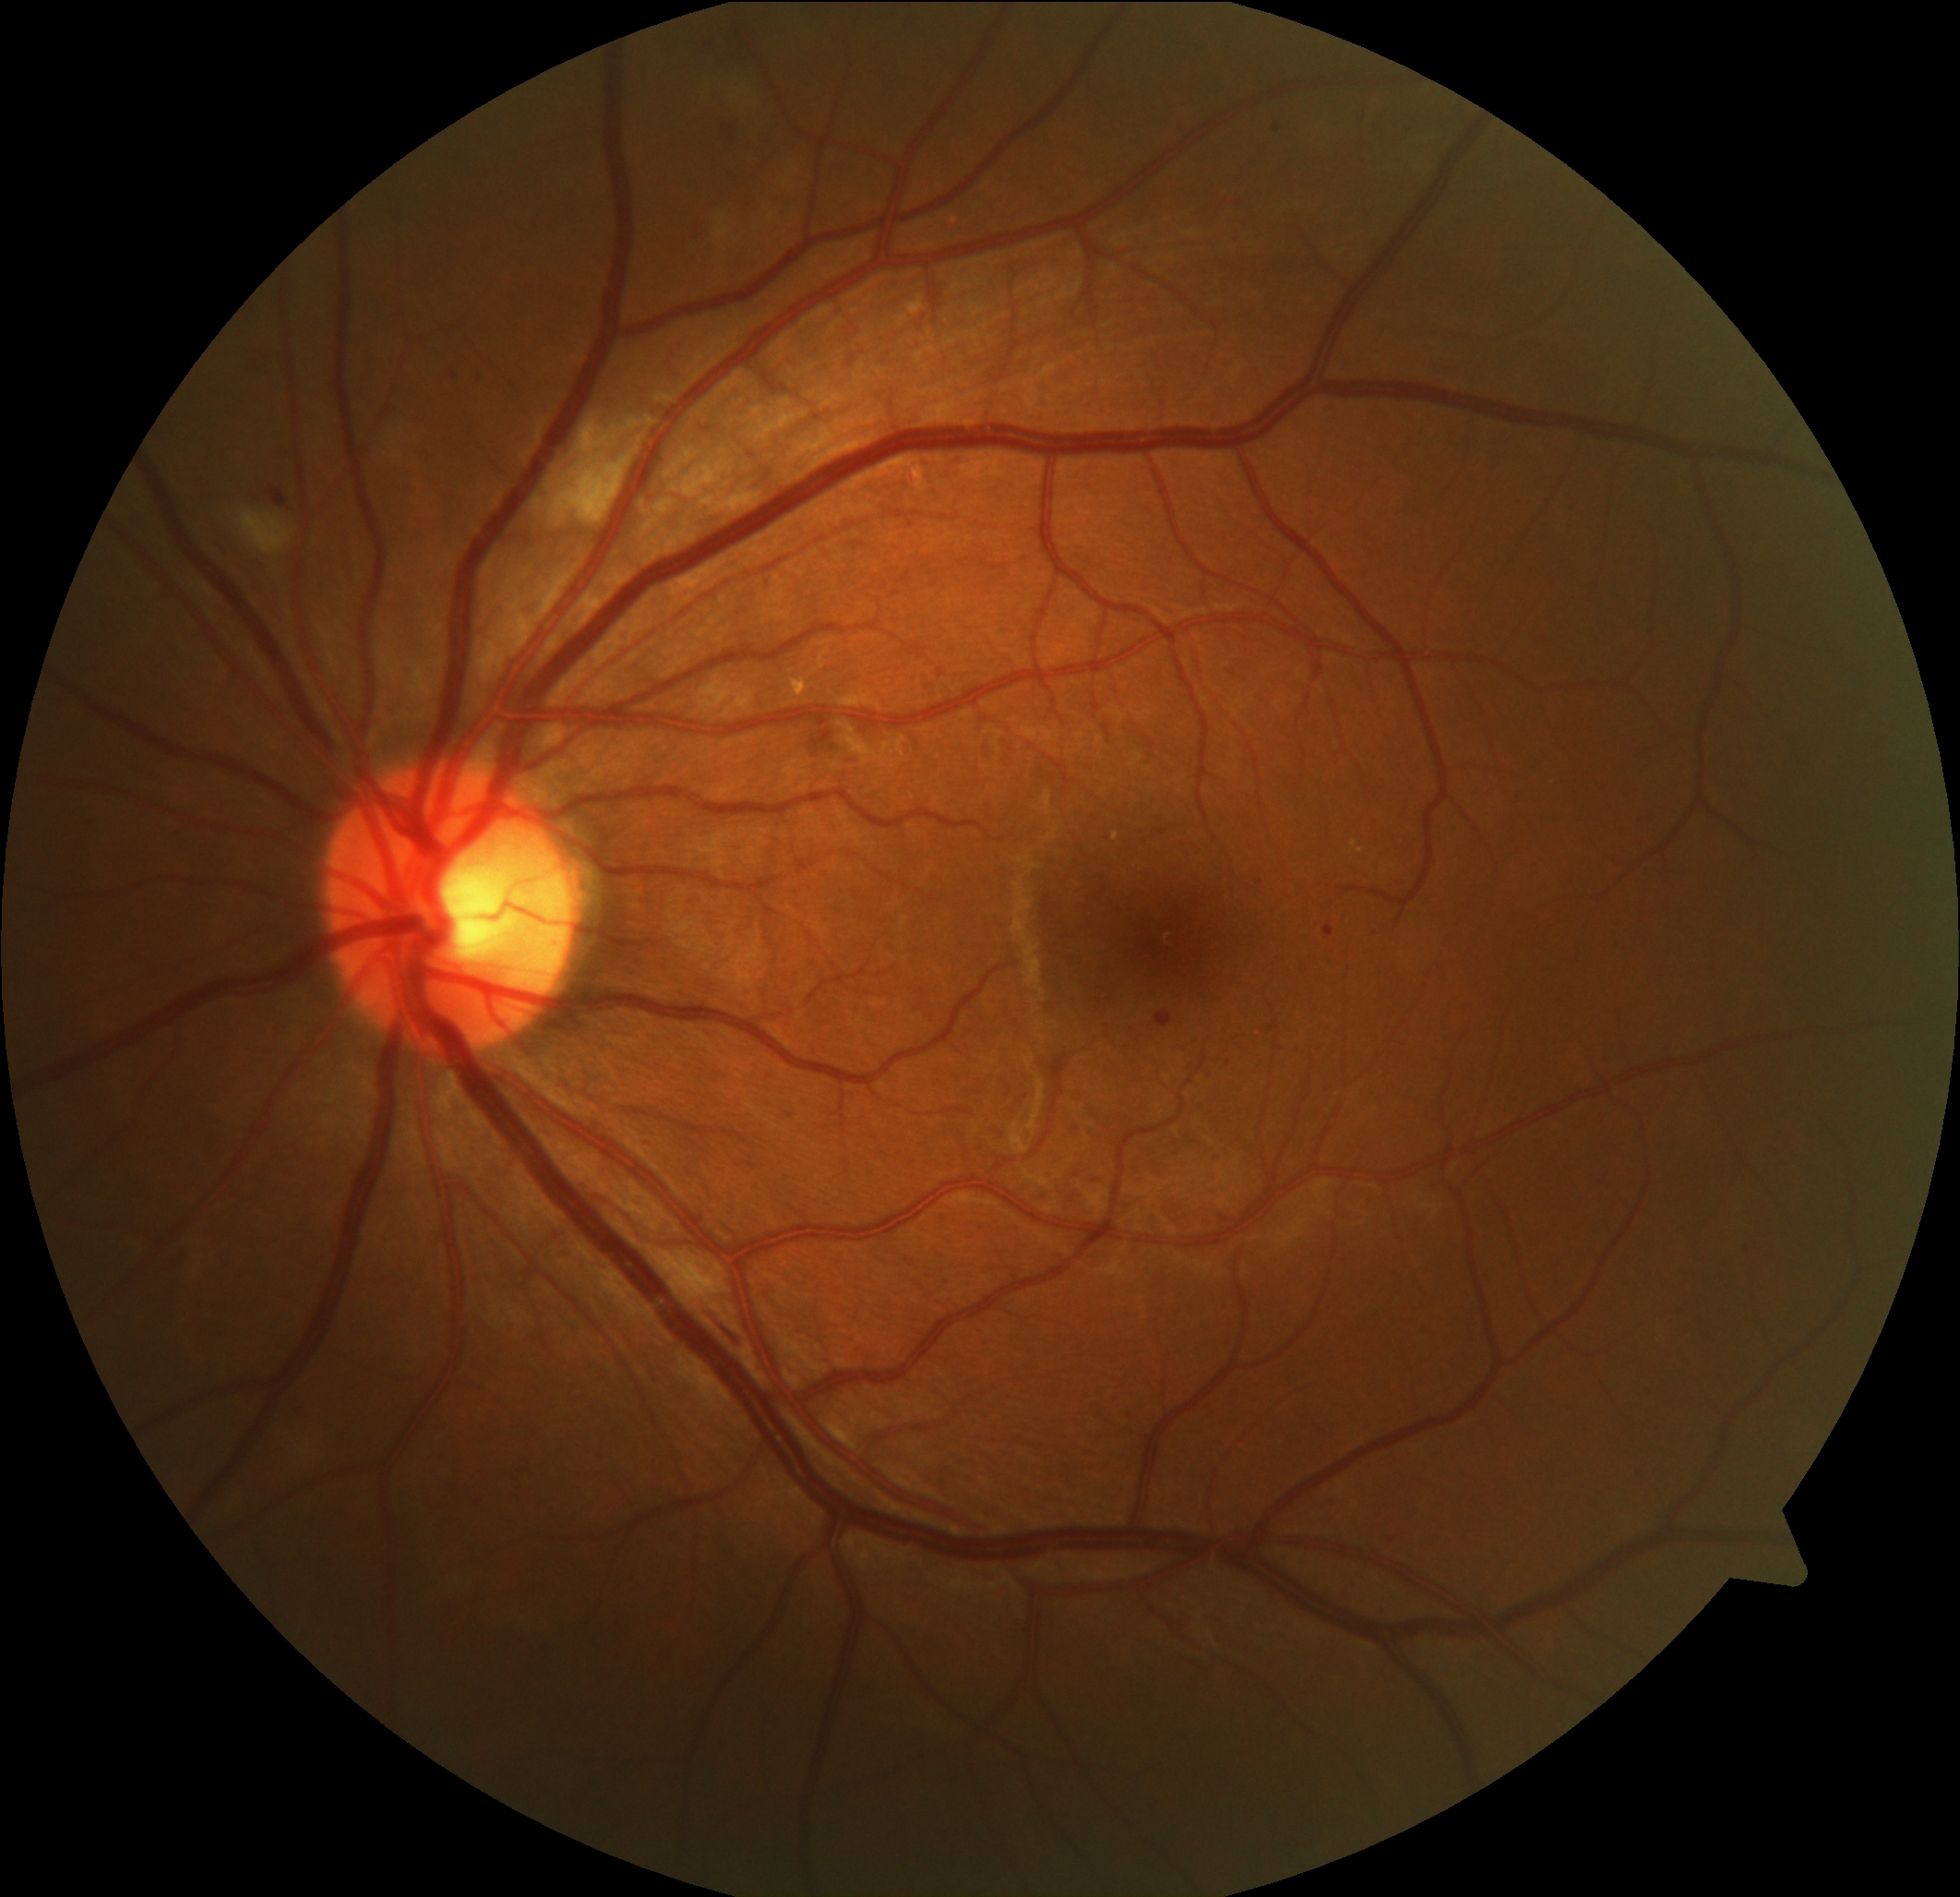

Diabetic retinopathy (DR): 2
Lesions identified (partial list):
hard exudates (EXs): absent
microaneurysms (MAs) (partial): rect(1155, 1013, 1173, 1026); rect(272, 490, 288, 505); rect(1323, 925, 1335, 938); rect(1273, 125, 1282, 131); rect(452, 373, 458, 381)
Smaller MAs around (x=1096, y=1181); (x=1260, y=883); (x=481, y=379)
hemorrhages (HEs): rect(711, 1309, 747, 1343); rect(711, 121, 738, 146); rect(700, 33, 748, 64)
soft exudates (SEs): rect(551, 424, 641, 528); rect(194, 1242, 209, 1279); rect(711, 213, 729, 242); rect(236, 508, 295, 556); rect(292, 1426, 318, 1460); rect(711, 71, 758, 115)